2102 x 1736 pixels — 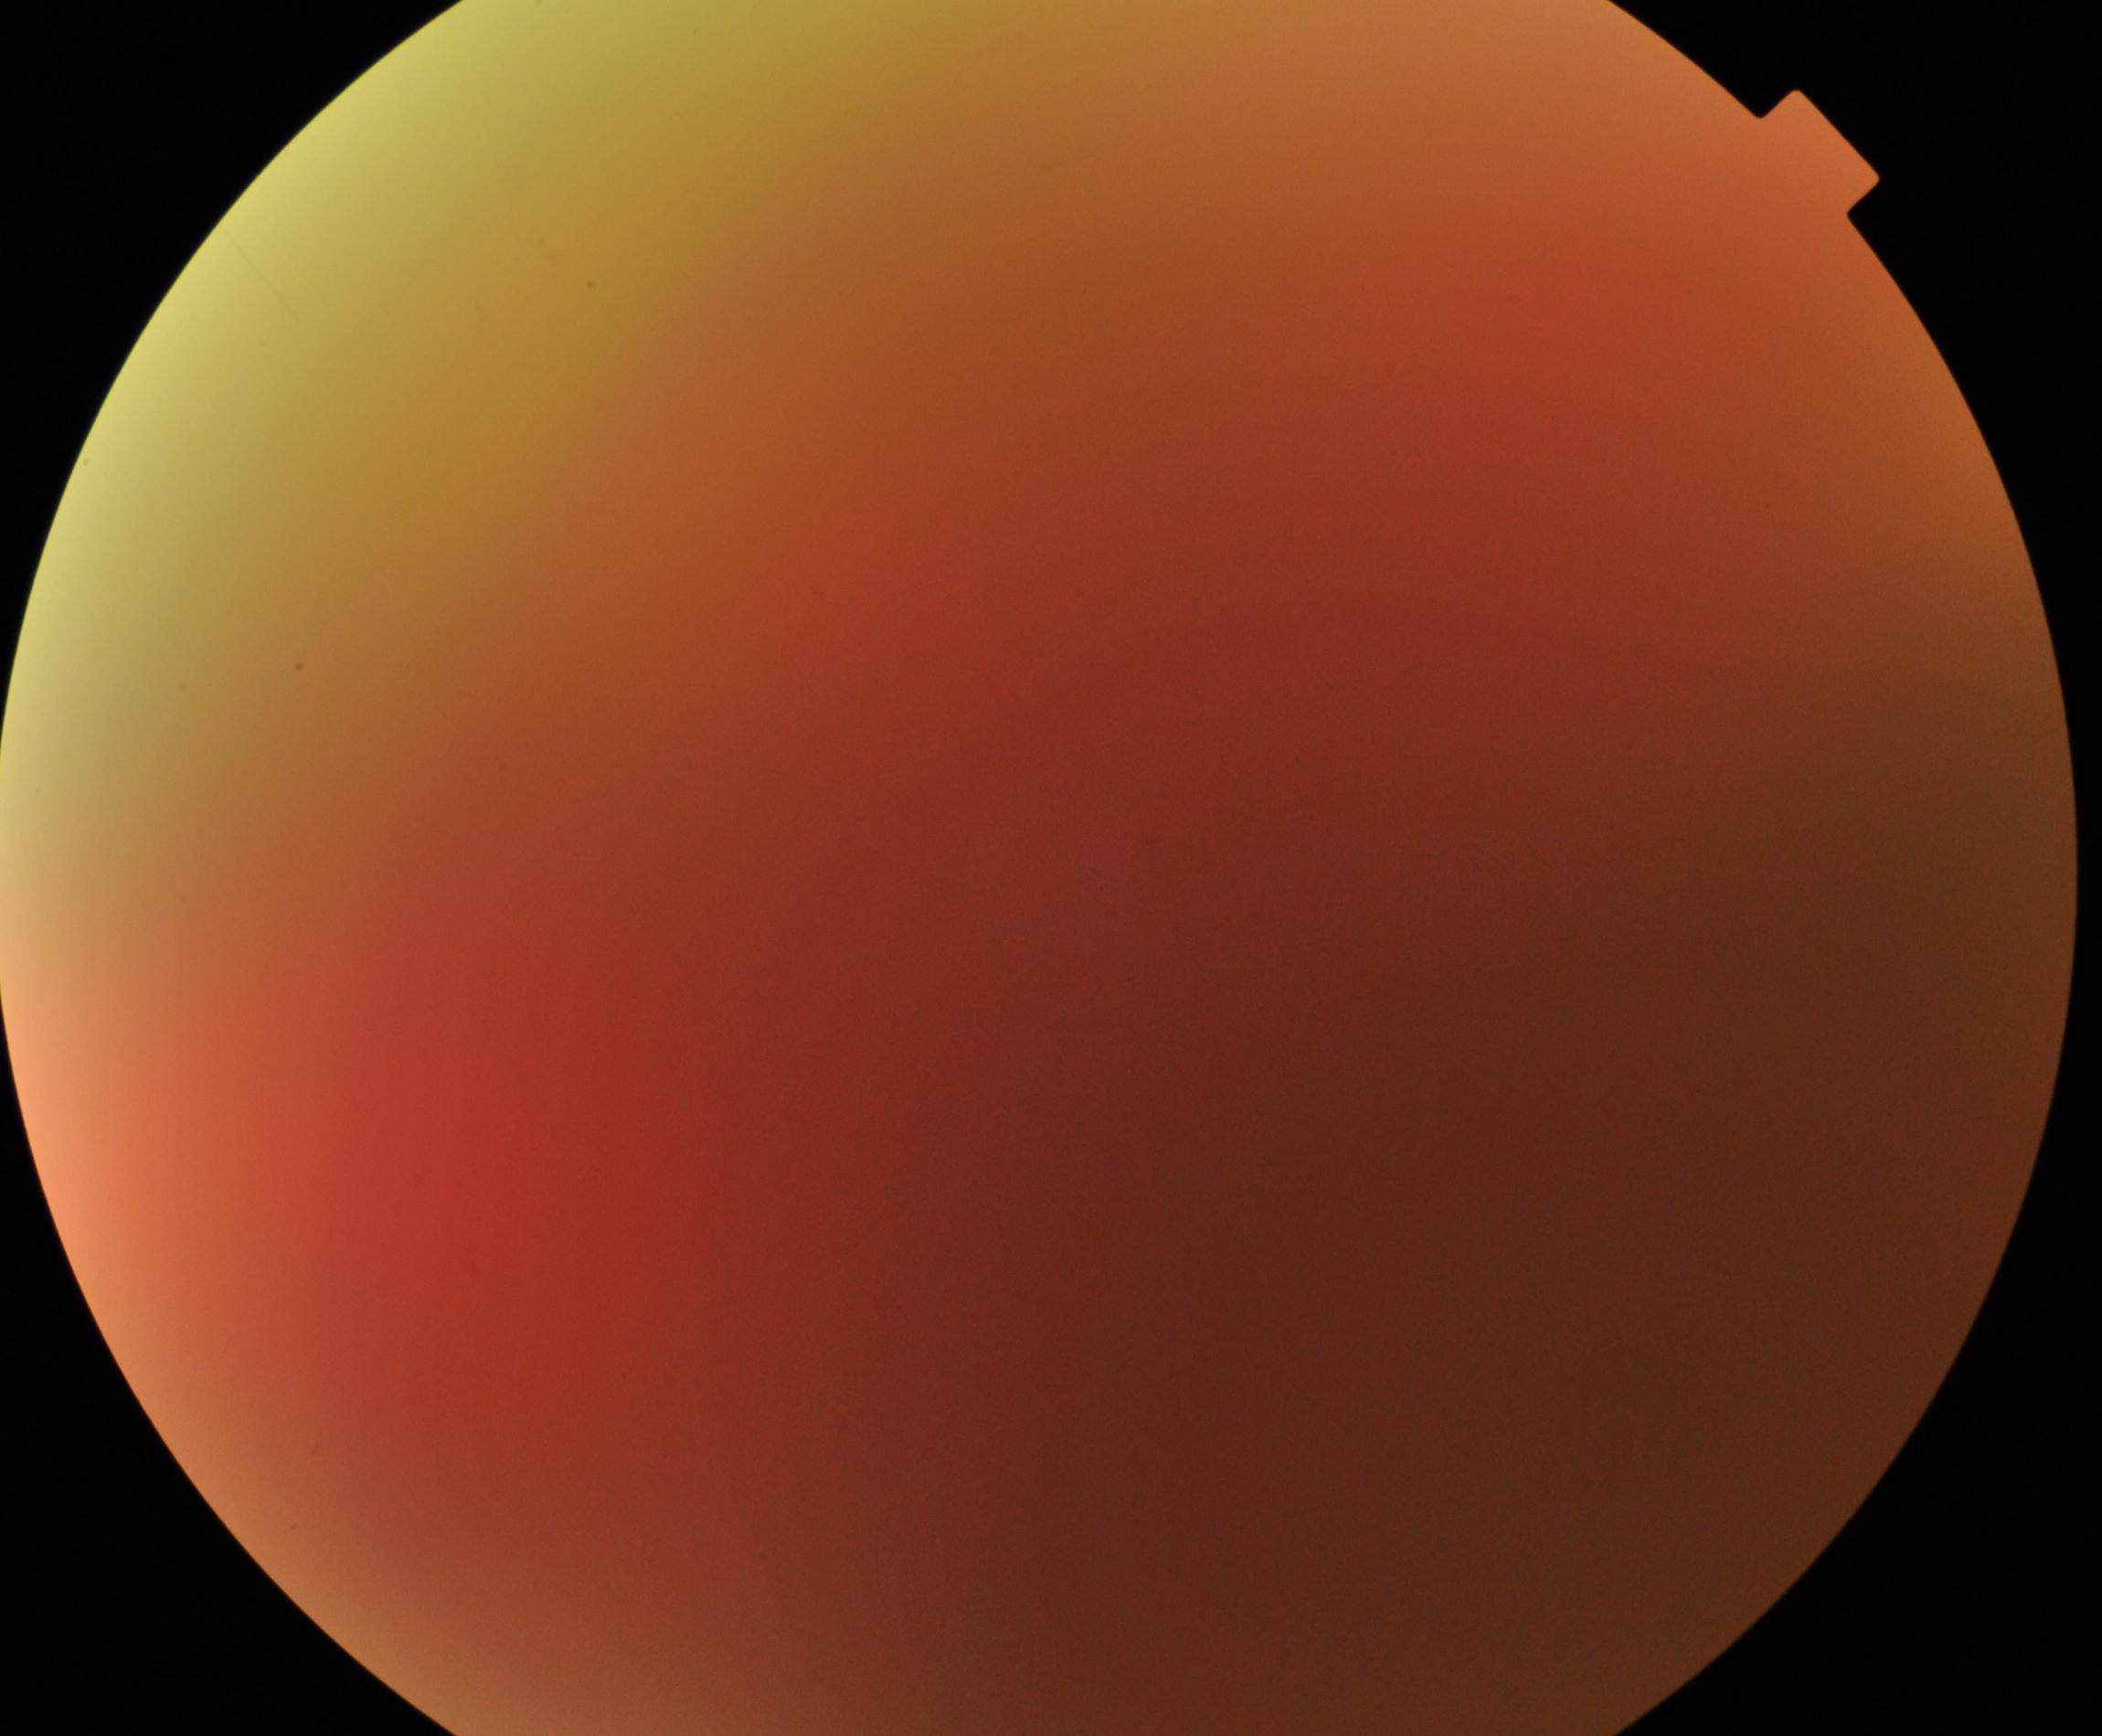

Image quality is poor; more than half the field is obscured. Proliferative diabetic retinopathy not identified in the visible portion.